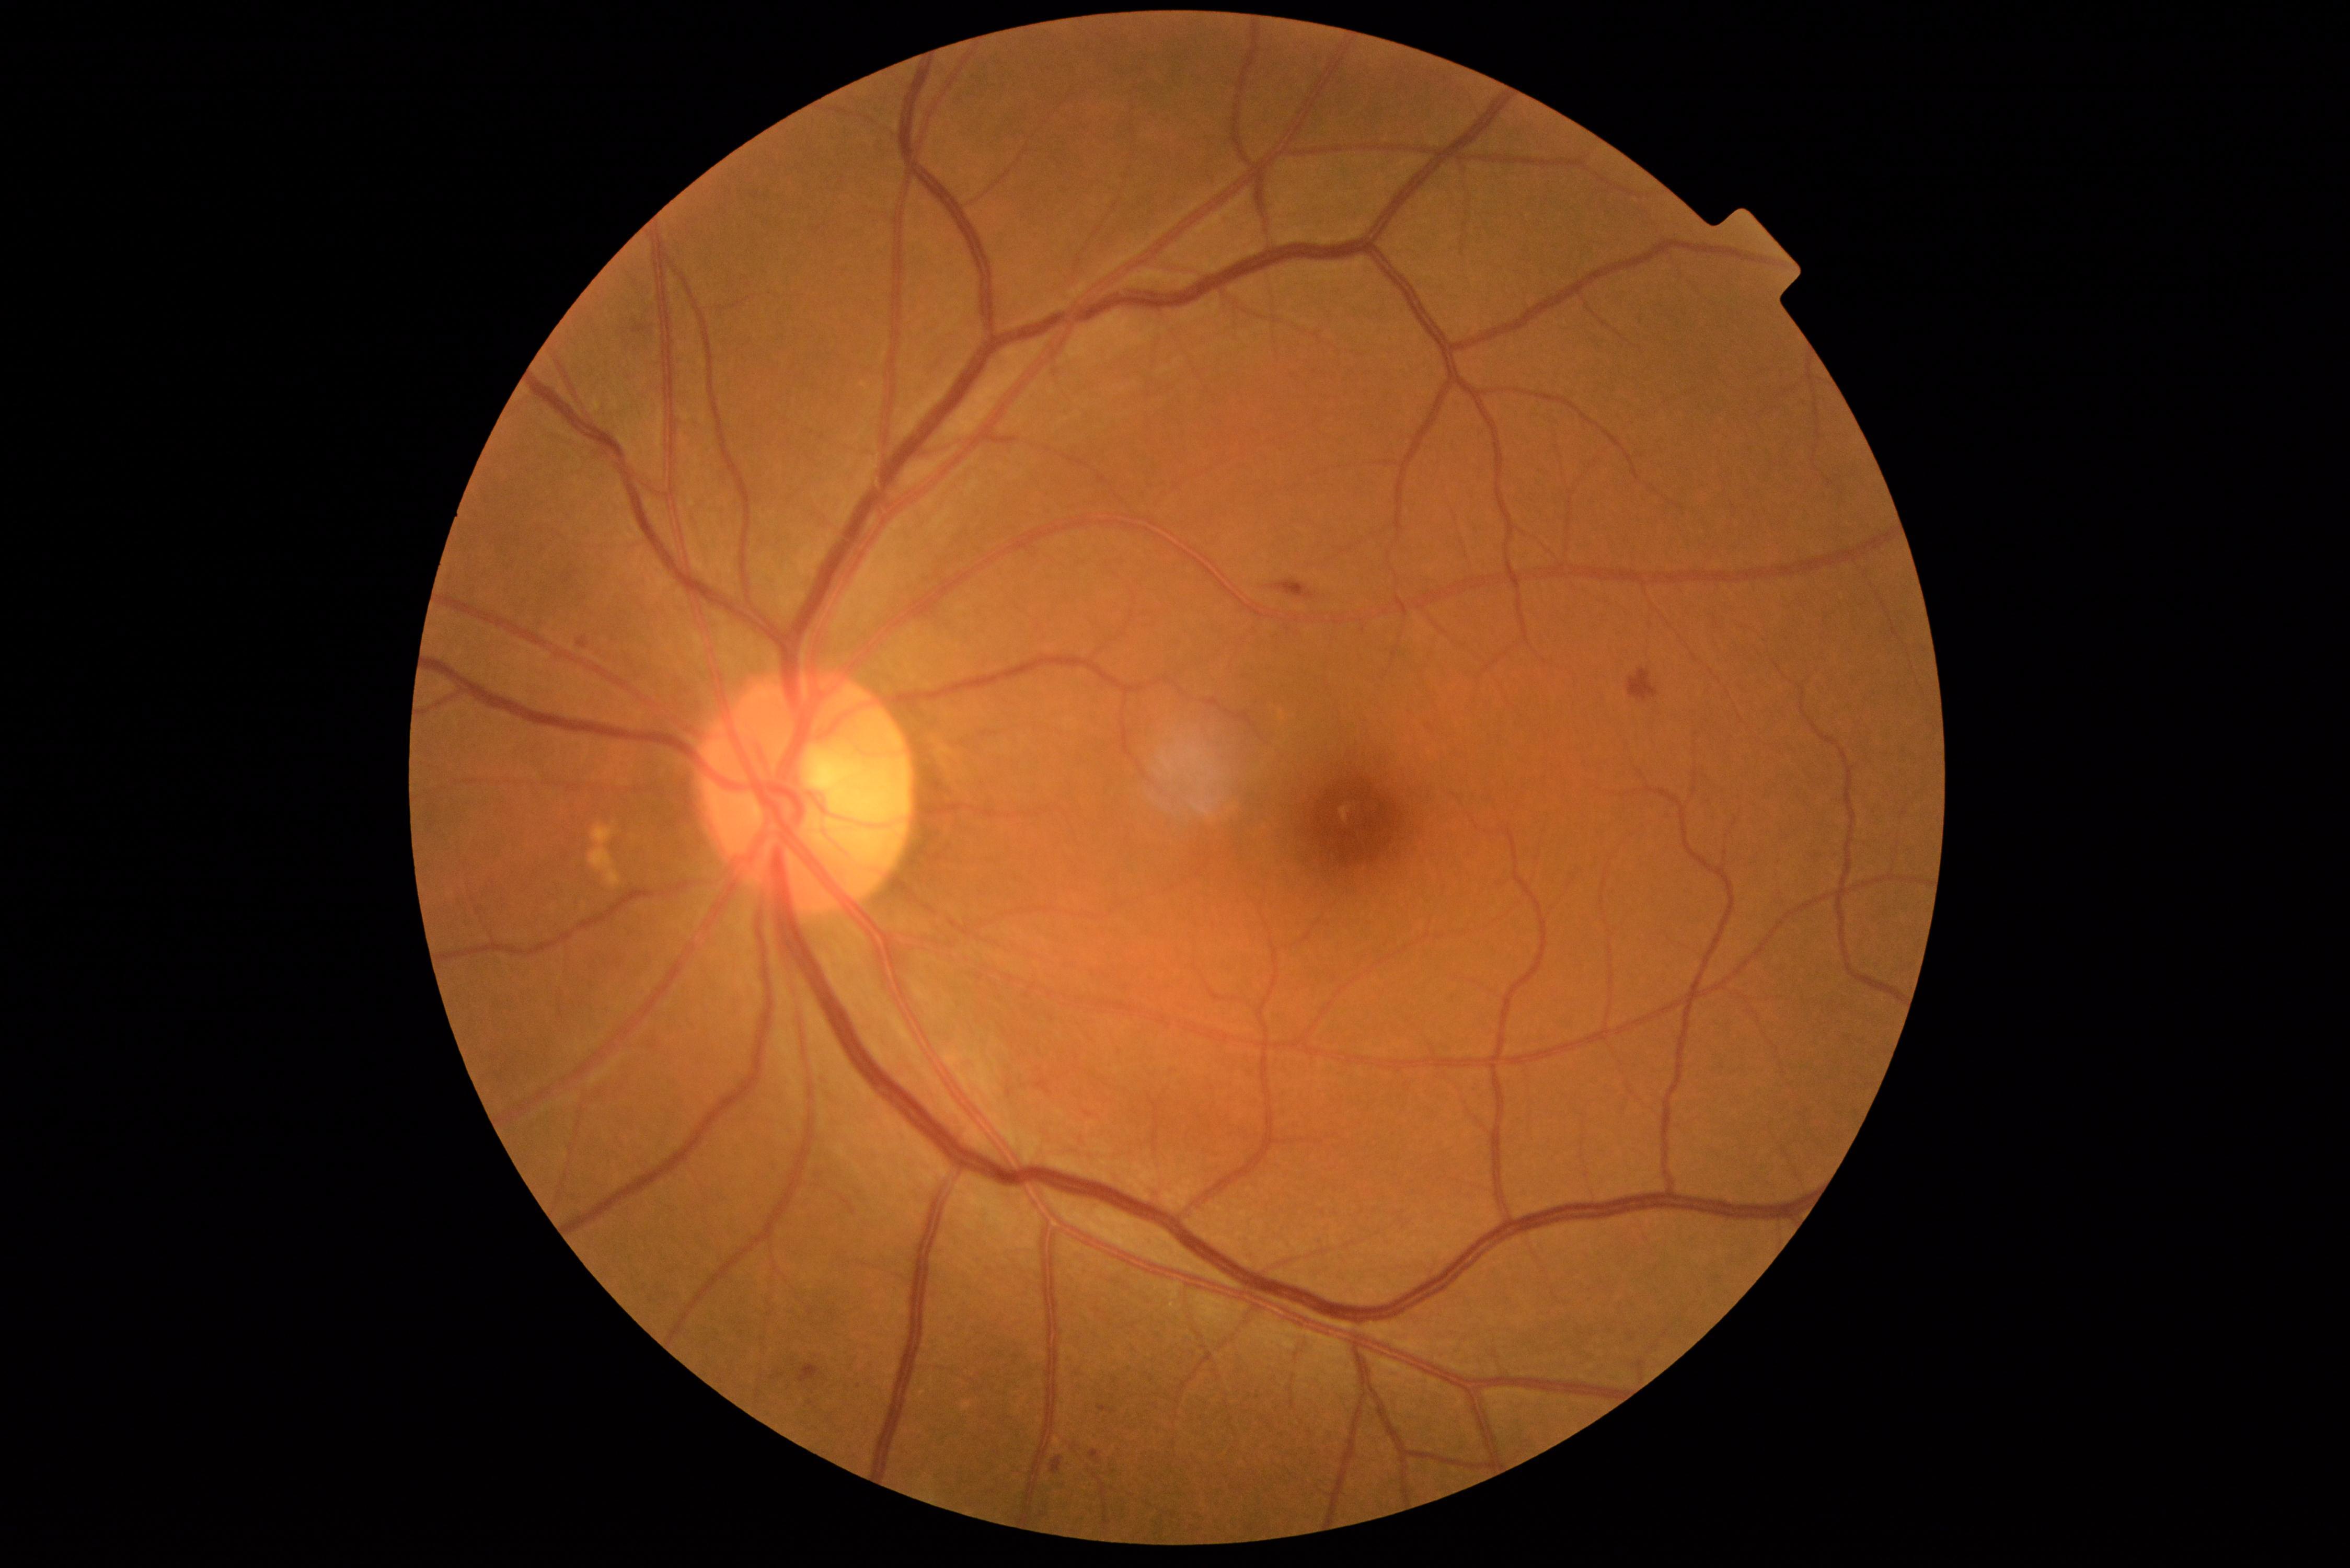 dr_grade: 2
lesions:
  se: []
  ex: []
  he:
    - [x1=577, y1=636, x2=589, y2=650]
    - [x1=798, y1=1364, x2=820, y2=1382]
    - [x1=1272, y1=579, x2=1315, y2=599]
    - [x1=1628, y1=670, x2=1660, y2=702]
    - [x1=1050, y1=1457, x2=1063, y2=1474]
  ma:
    - [x1=1098, y1=1405, x2=1104, y2=1413]
    - [x1=1090, y1=1449, x2=1100, y2=1464]
  ma_small:
    - [x=857, y=1382]